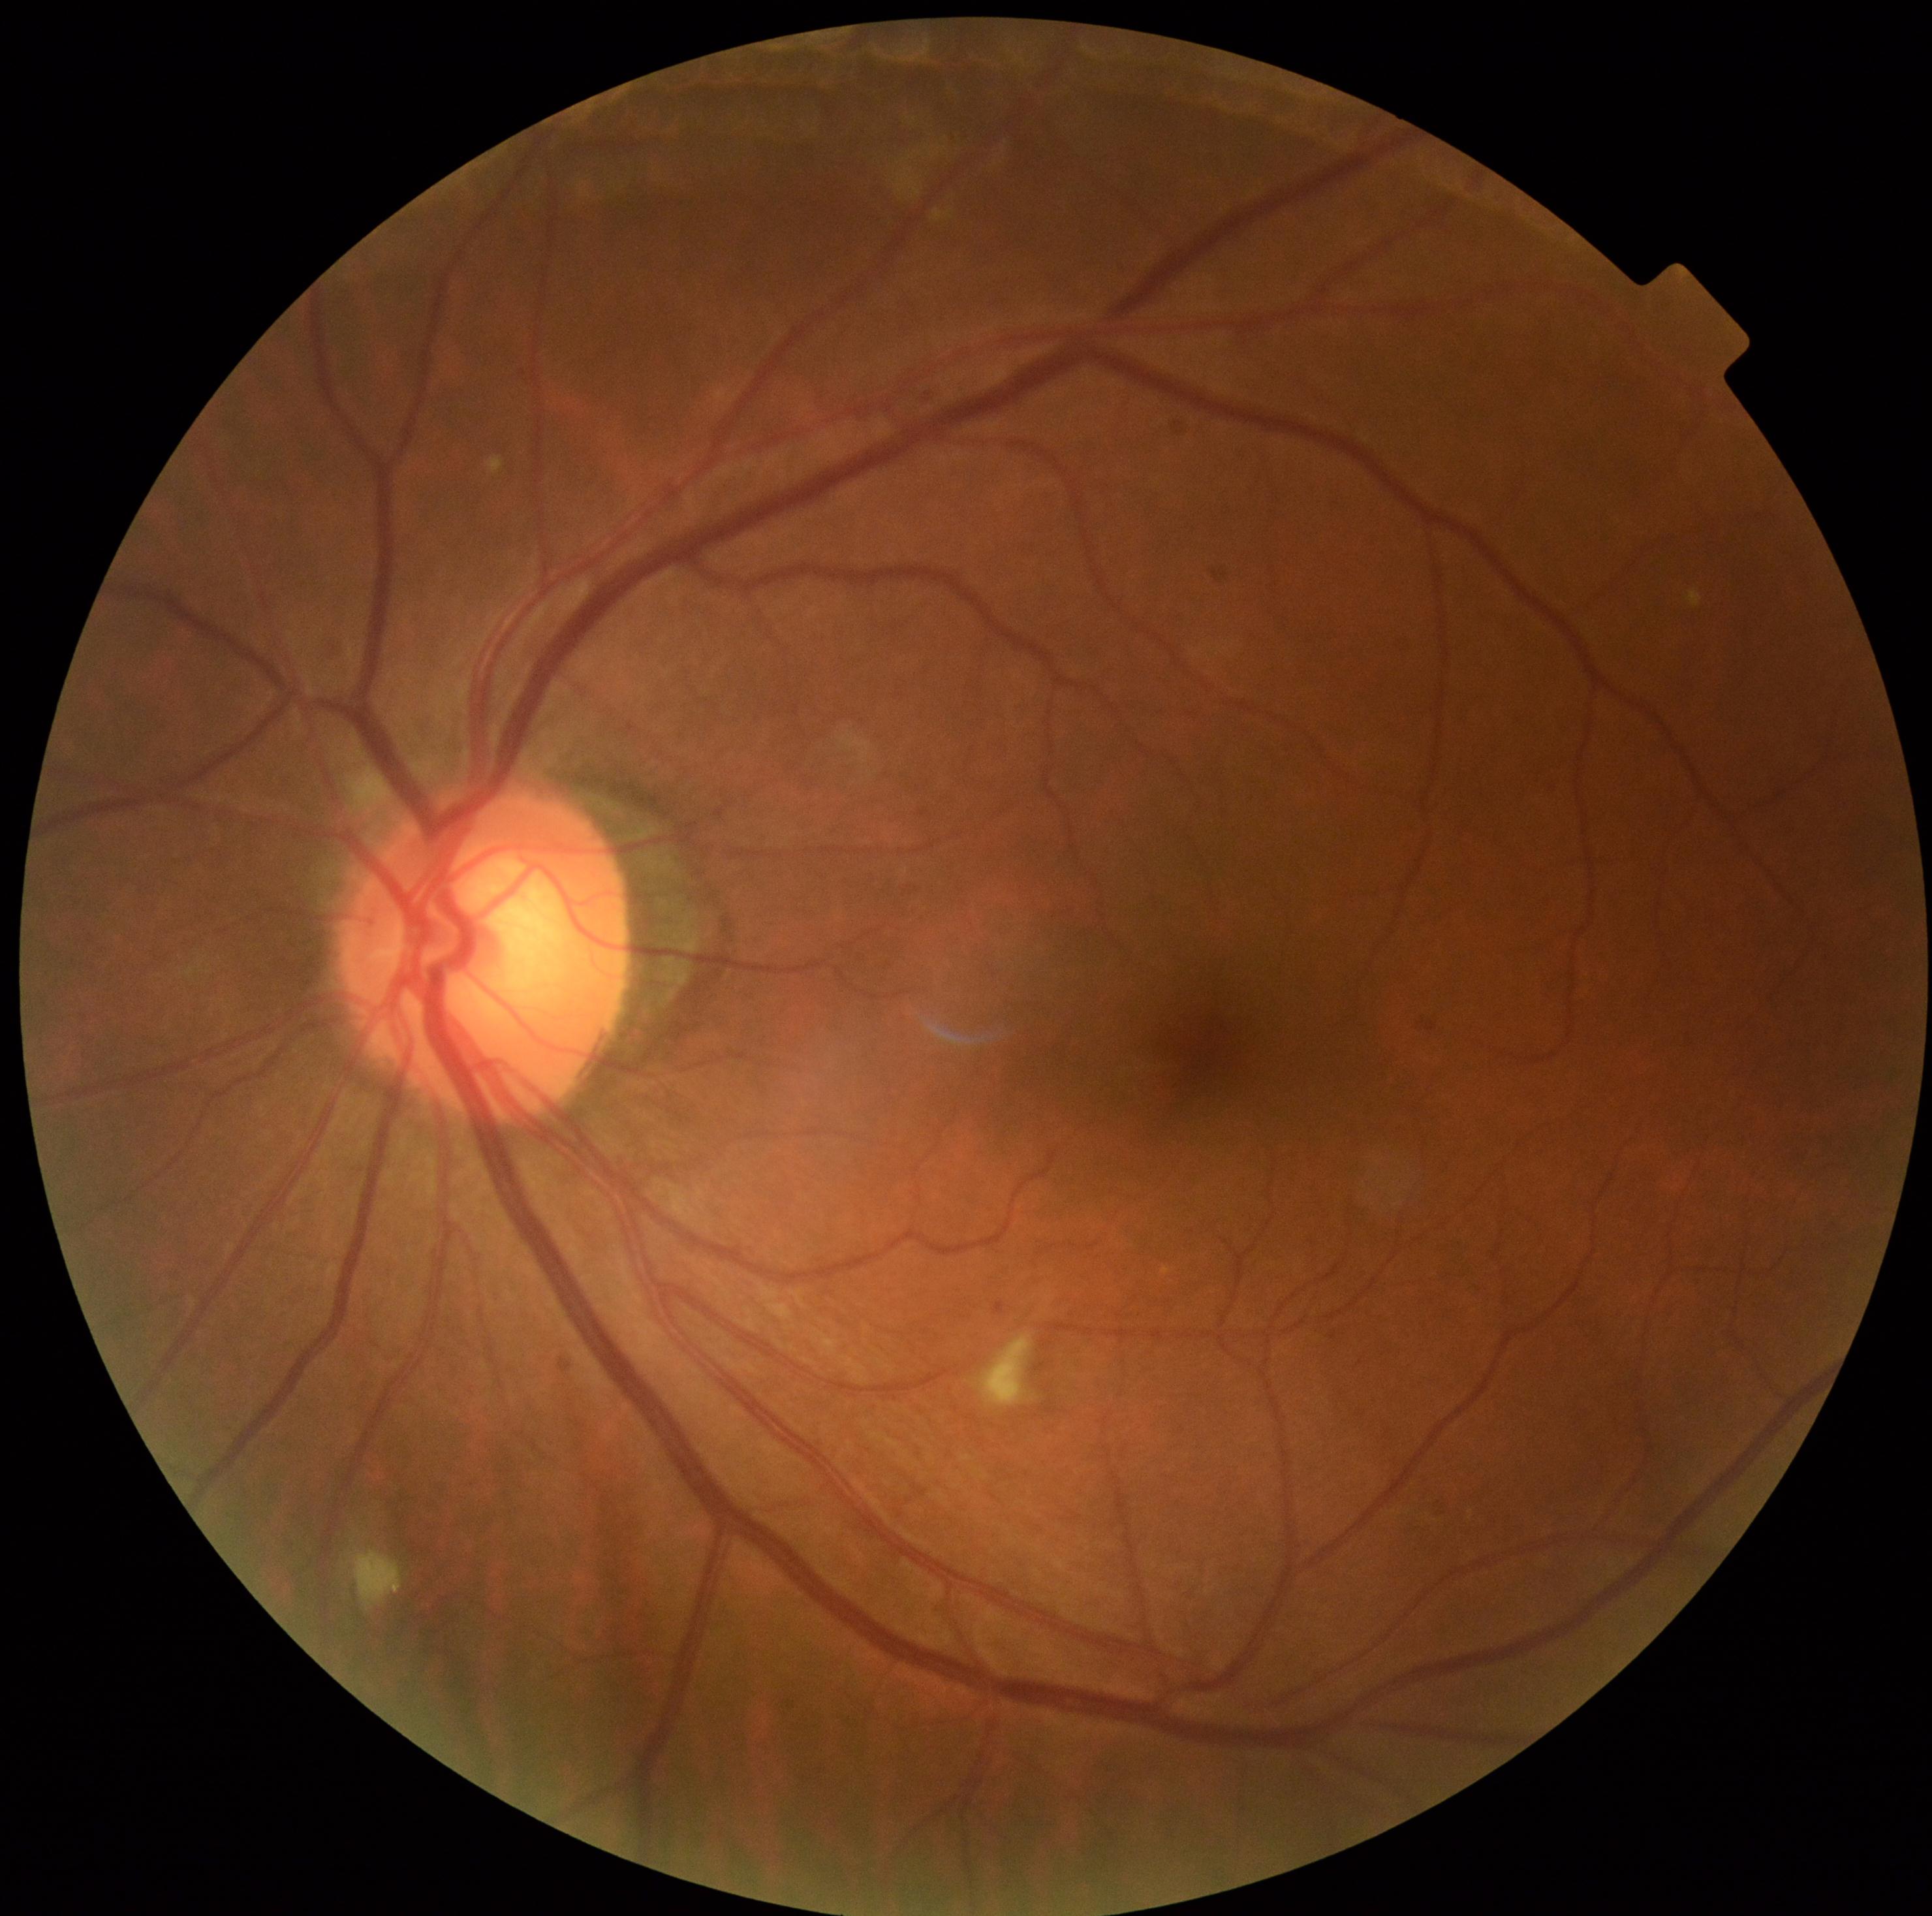

Retinopathy: 2 — more than just microaneurysms but less than severe NPDR
microaneurysms: rect(334, 645, 354, 663), rect(994, 1300, 1005, 1313), rect(916, 380, 943, 402)
soft exudates: rect(348, 1547, 403, 1610), rect(973, 1333, 1037, 1407)
hemorrhages: absent
hard exudates: absent